Pupil-dilated, macula-centered field:
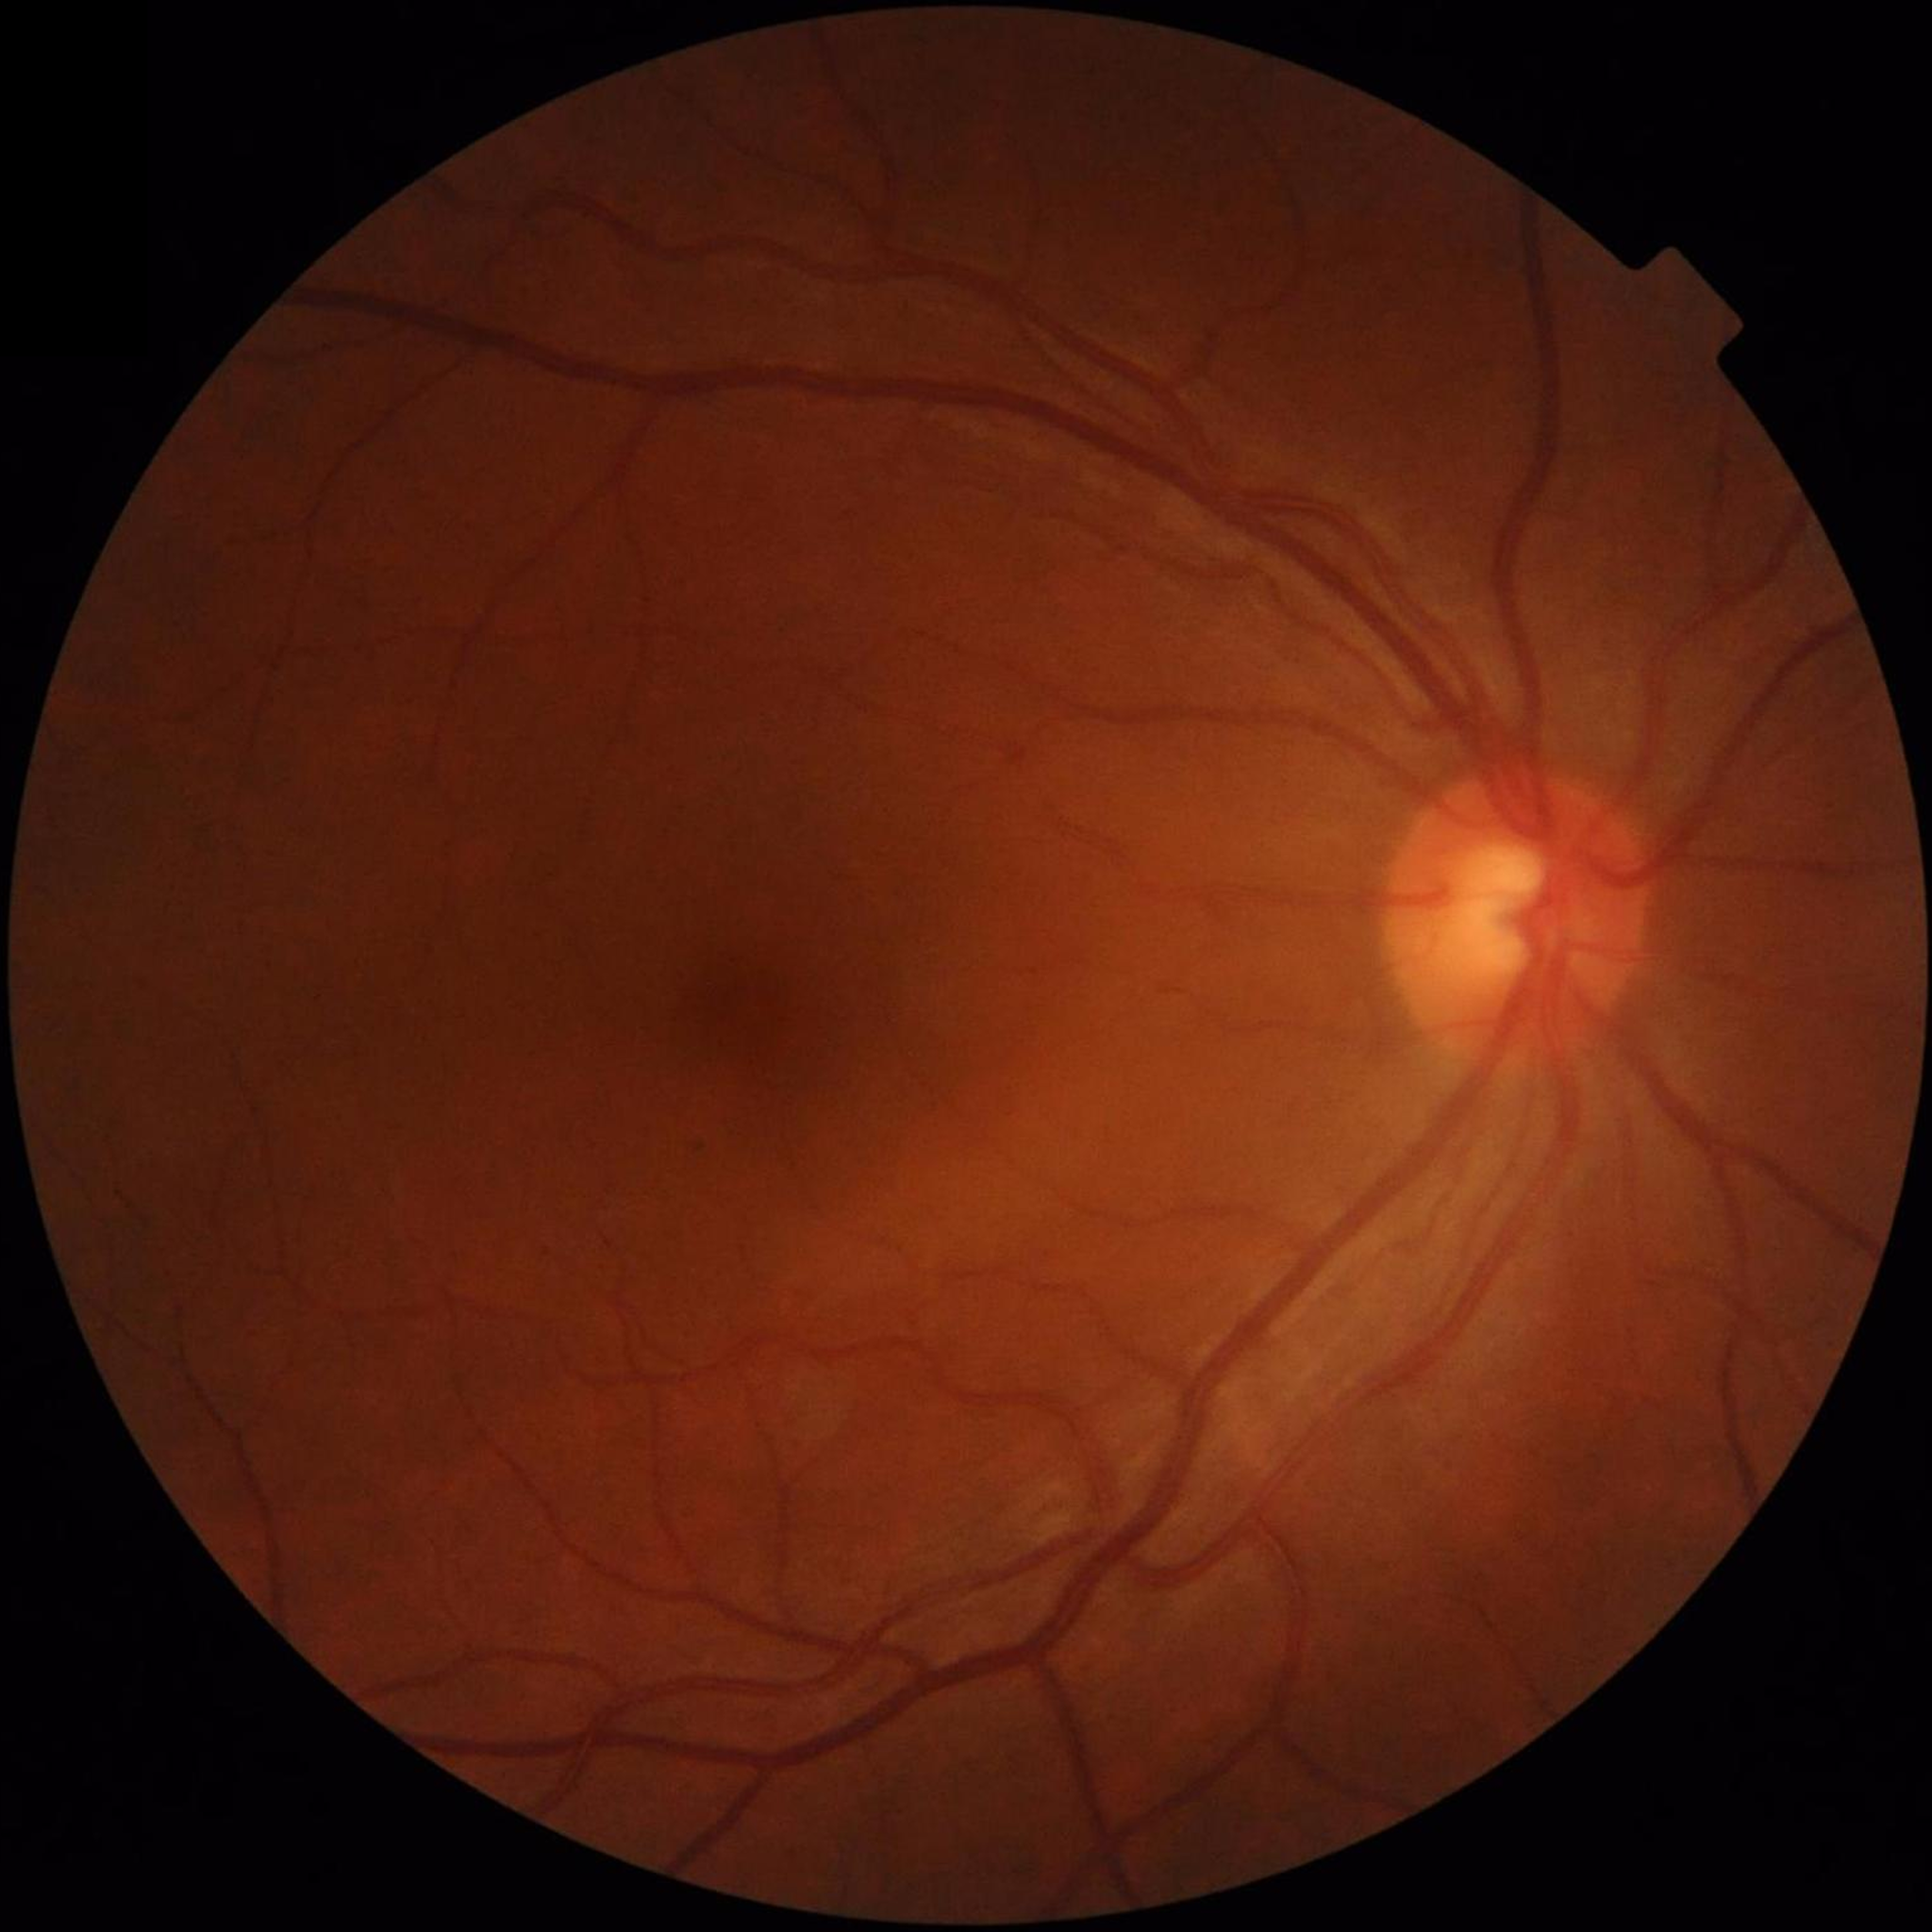 No findings of AMD, diabetic retinopathy, or glaucoma. Image quality: satisfactory.